RetCam wide-field infant fundus image: 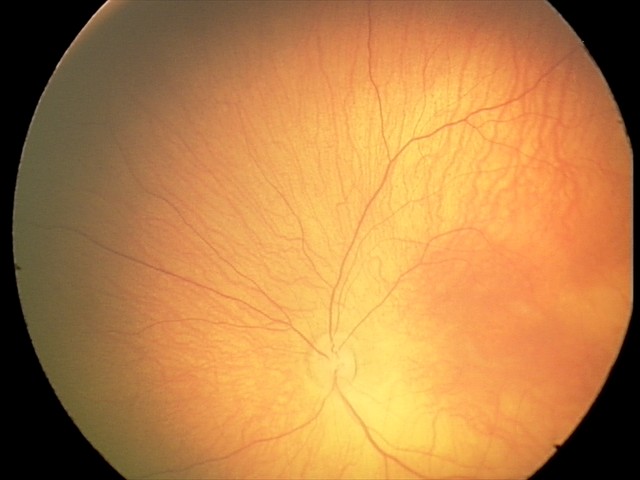
Screening diagnosis: retinal hemorrhages.